Infant wide-field retinal image · 1240x1240px · 100° field of view (Phoenix ICON).
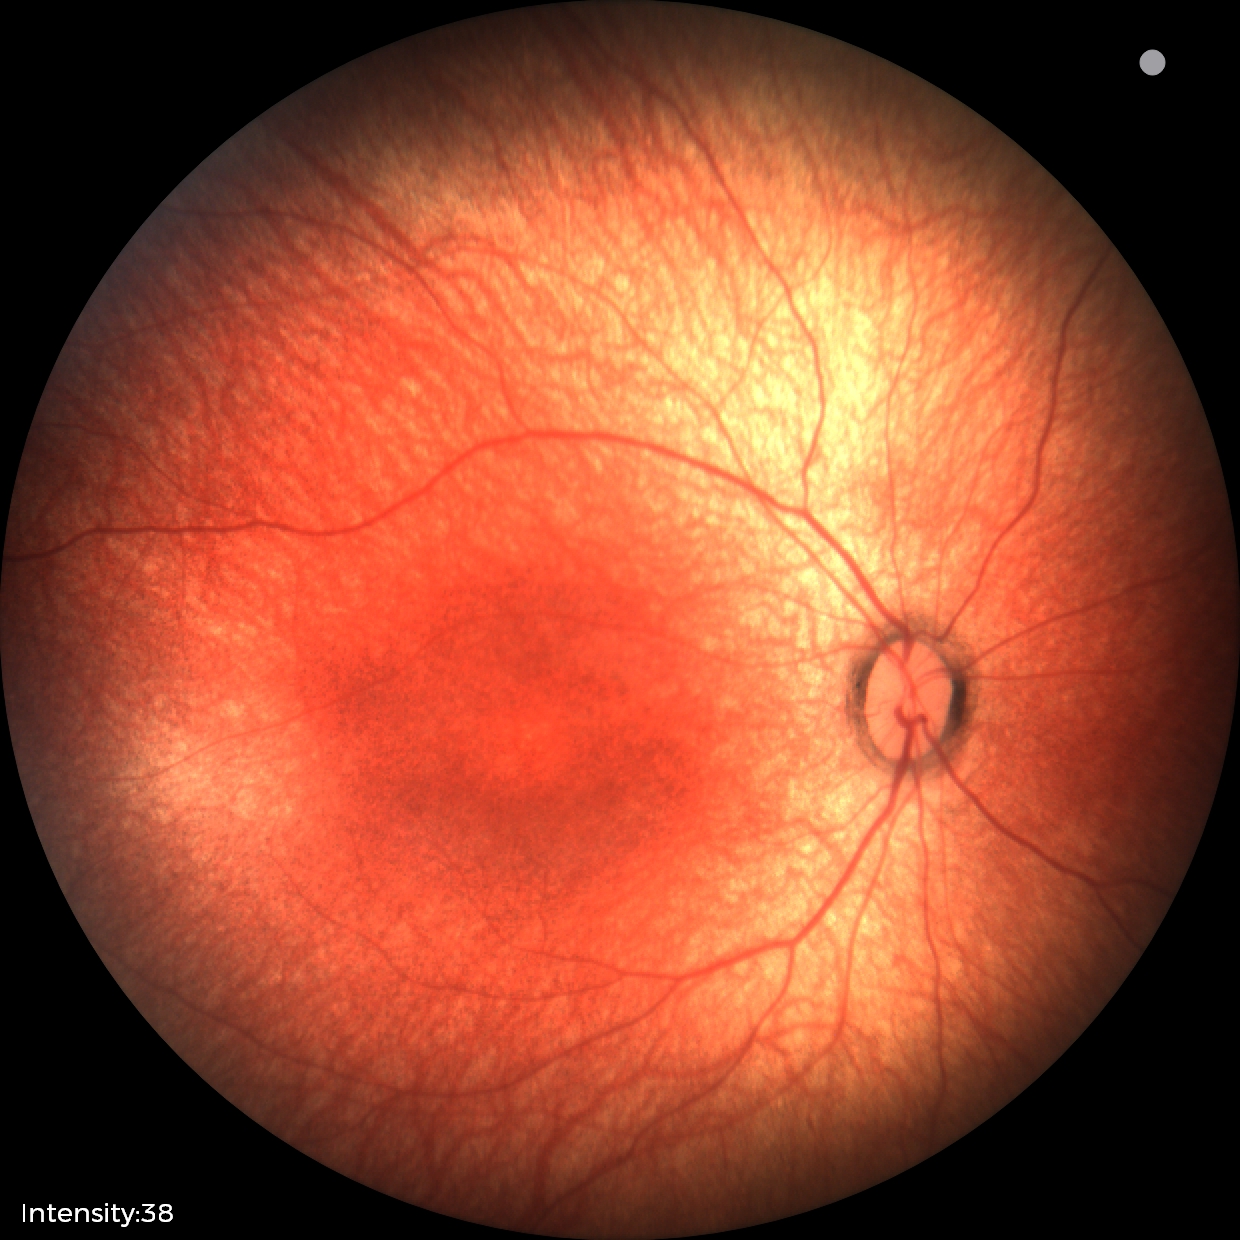 Screening examination with no abnormal retinal findings.